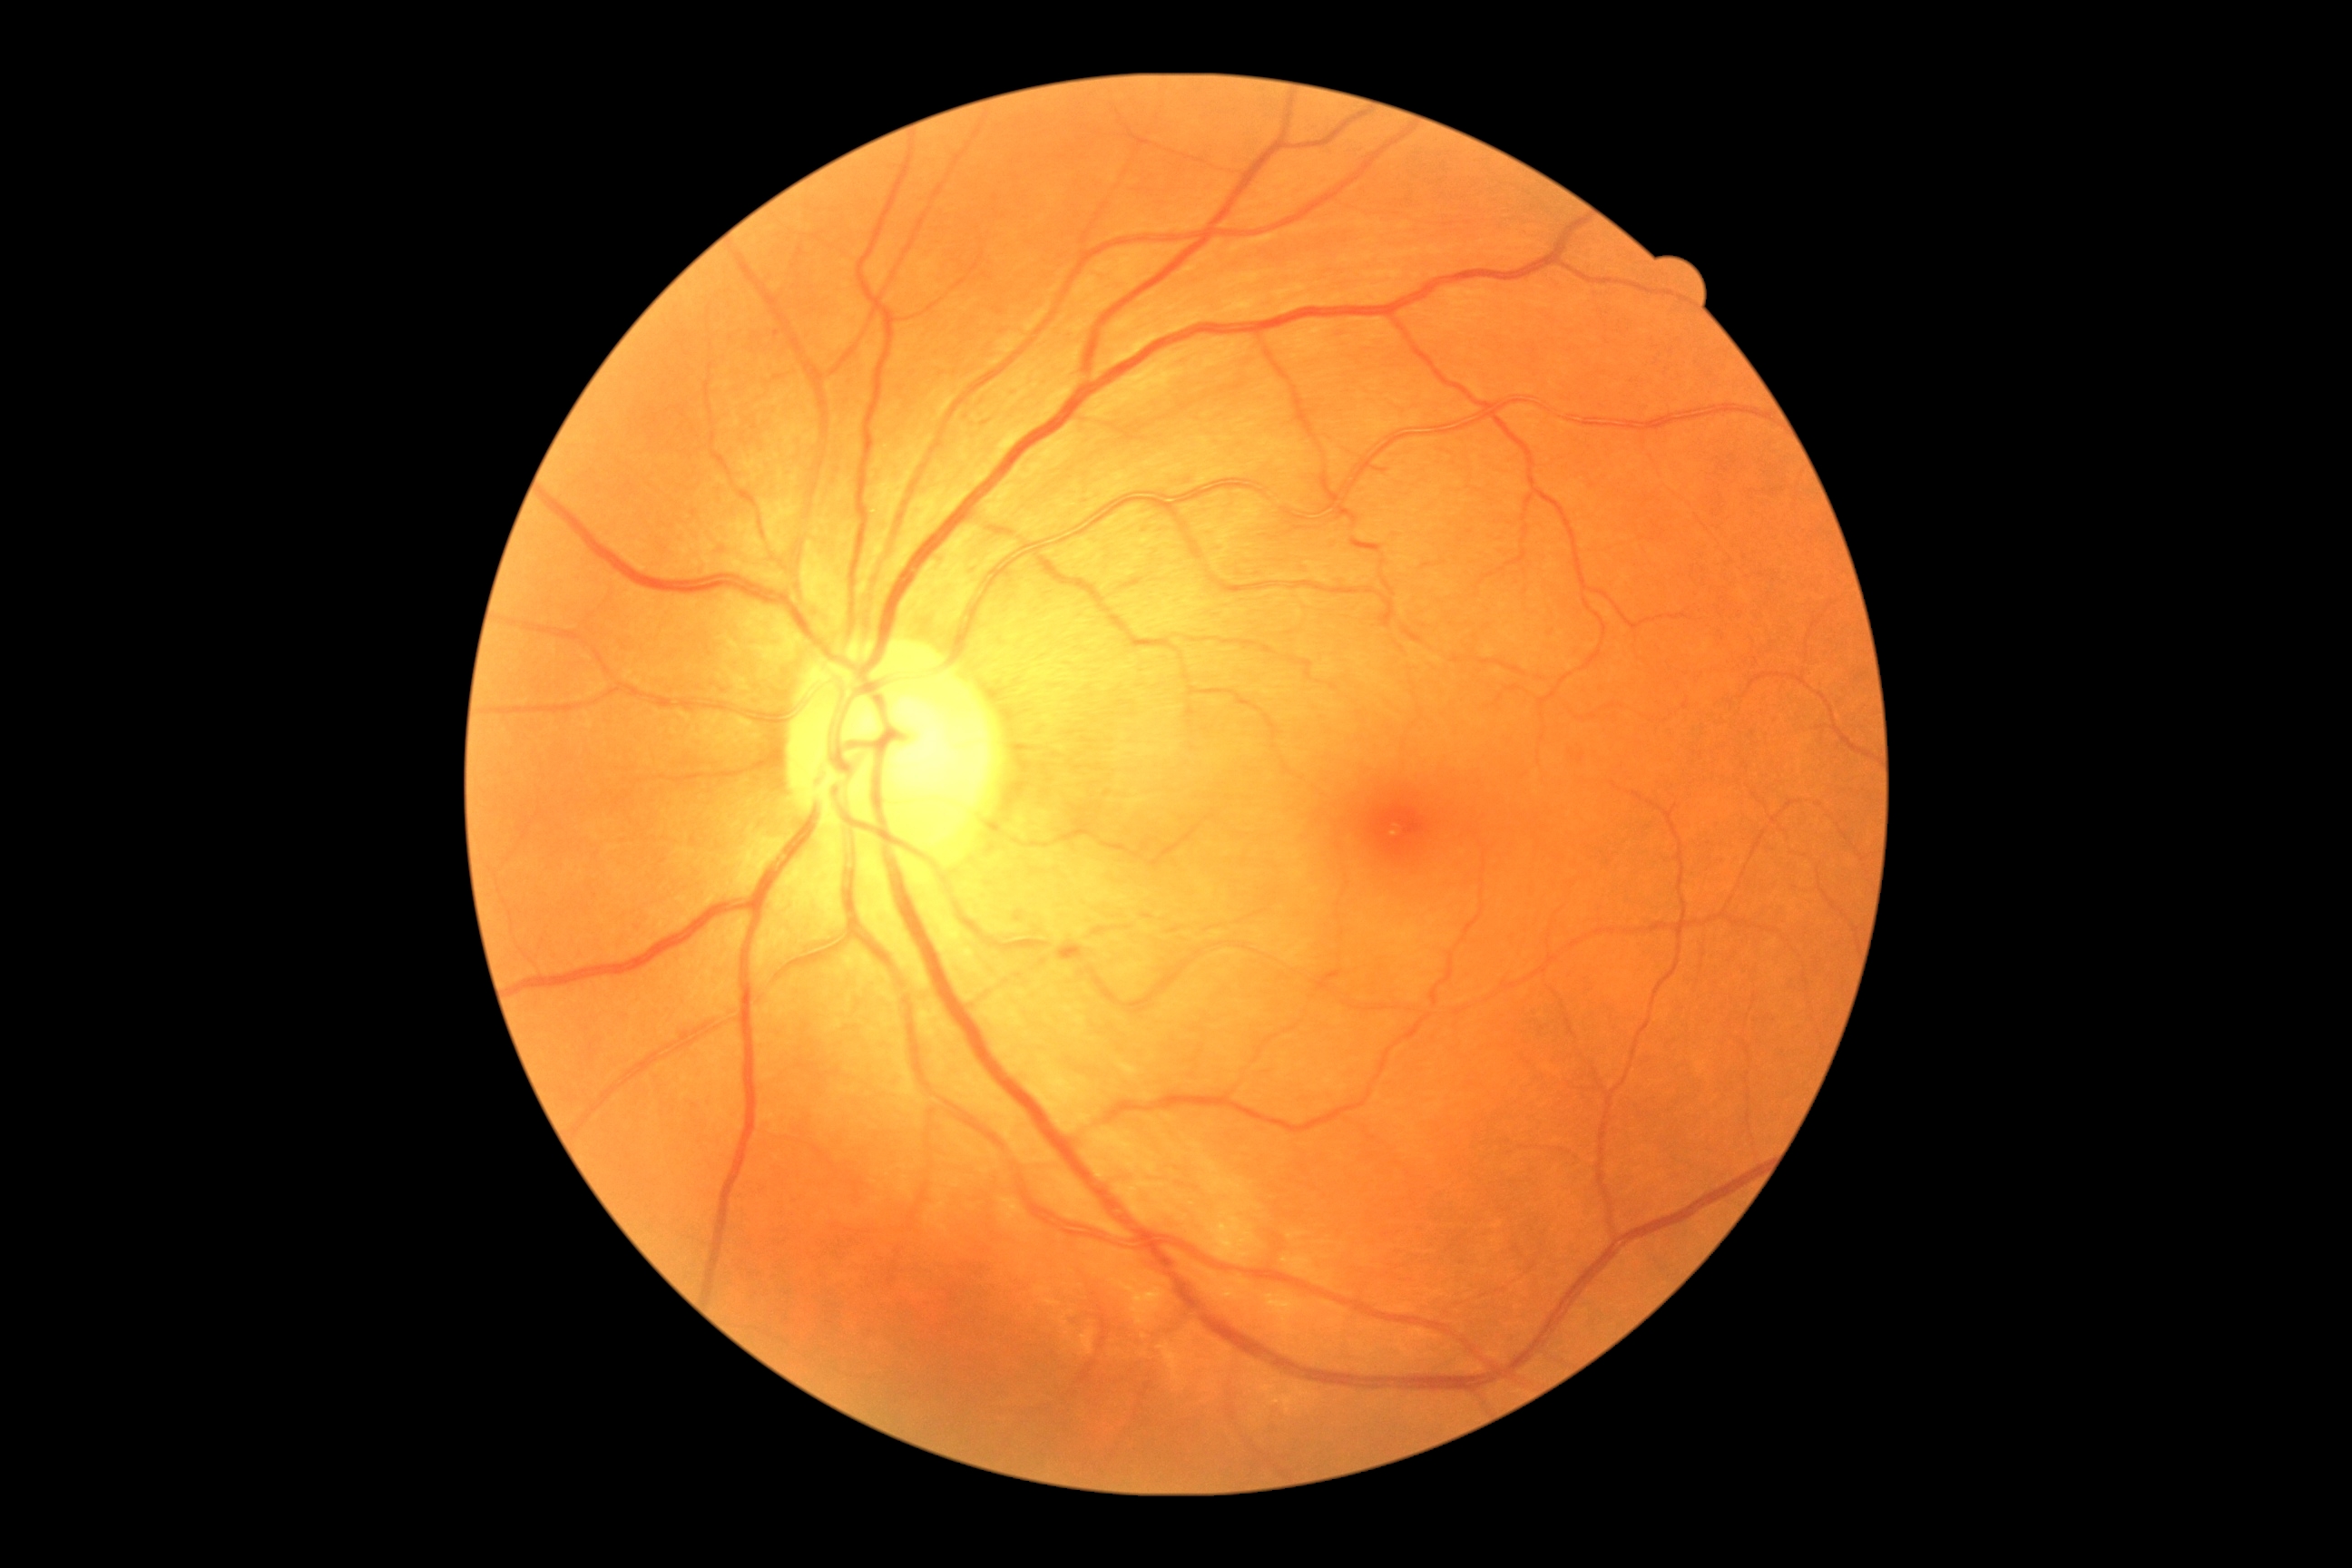

dr_grade: grade 0 — no visible signs of diabetic retinopathy